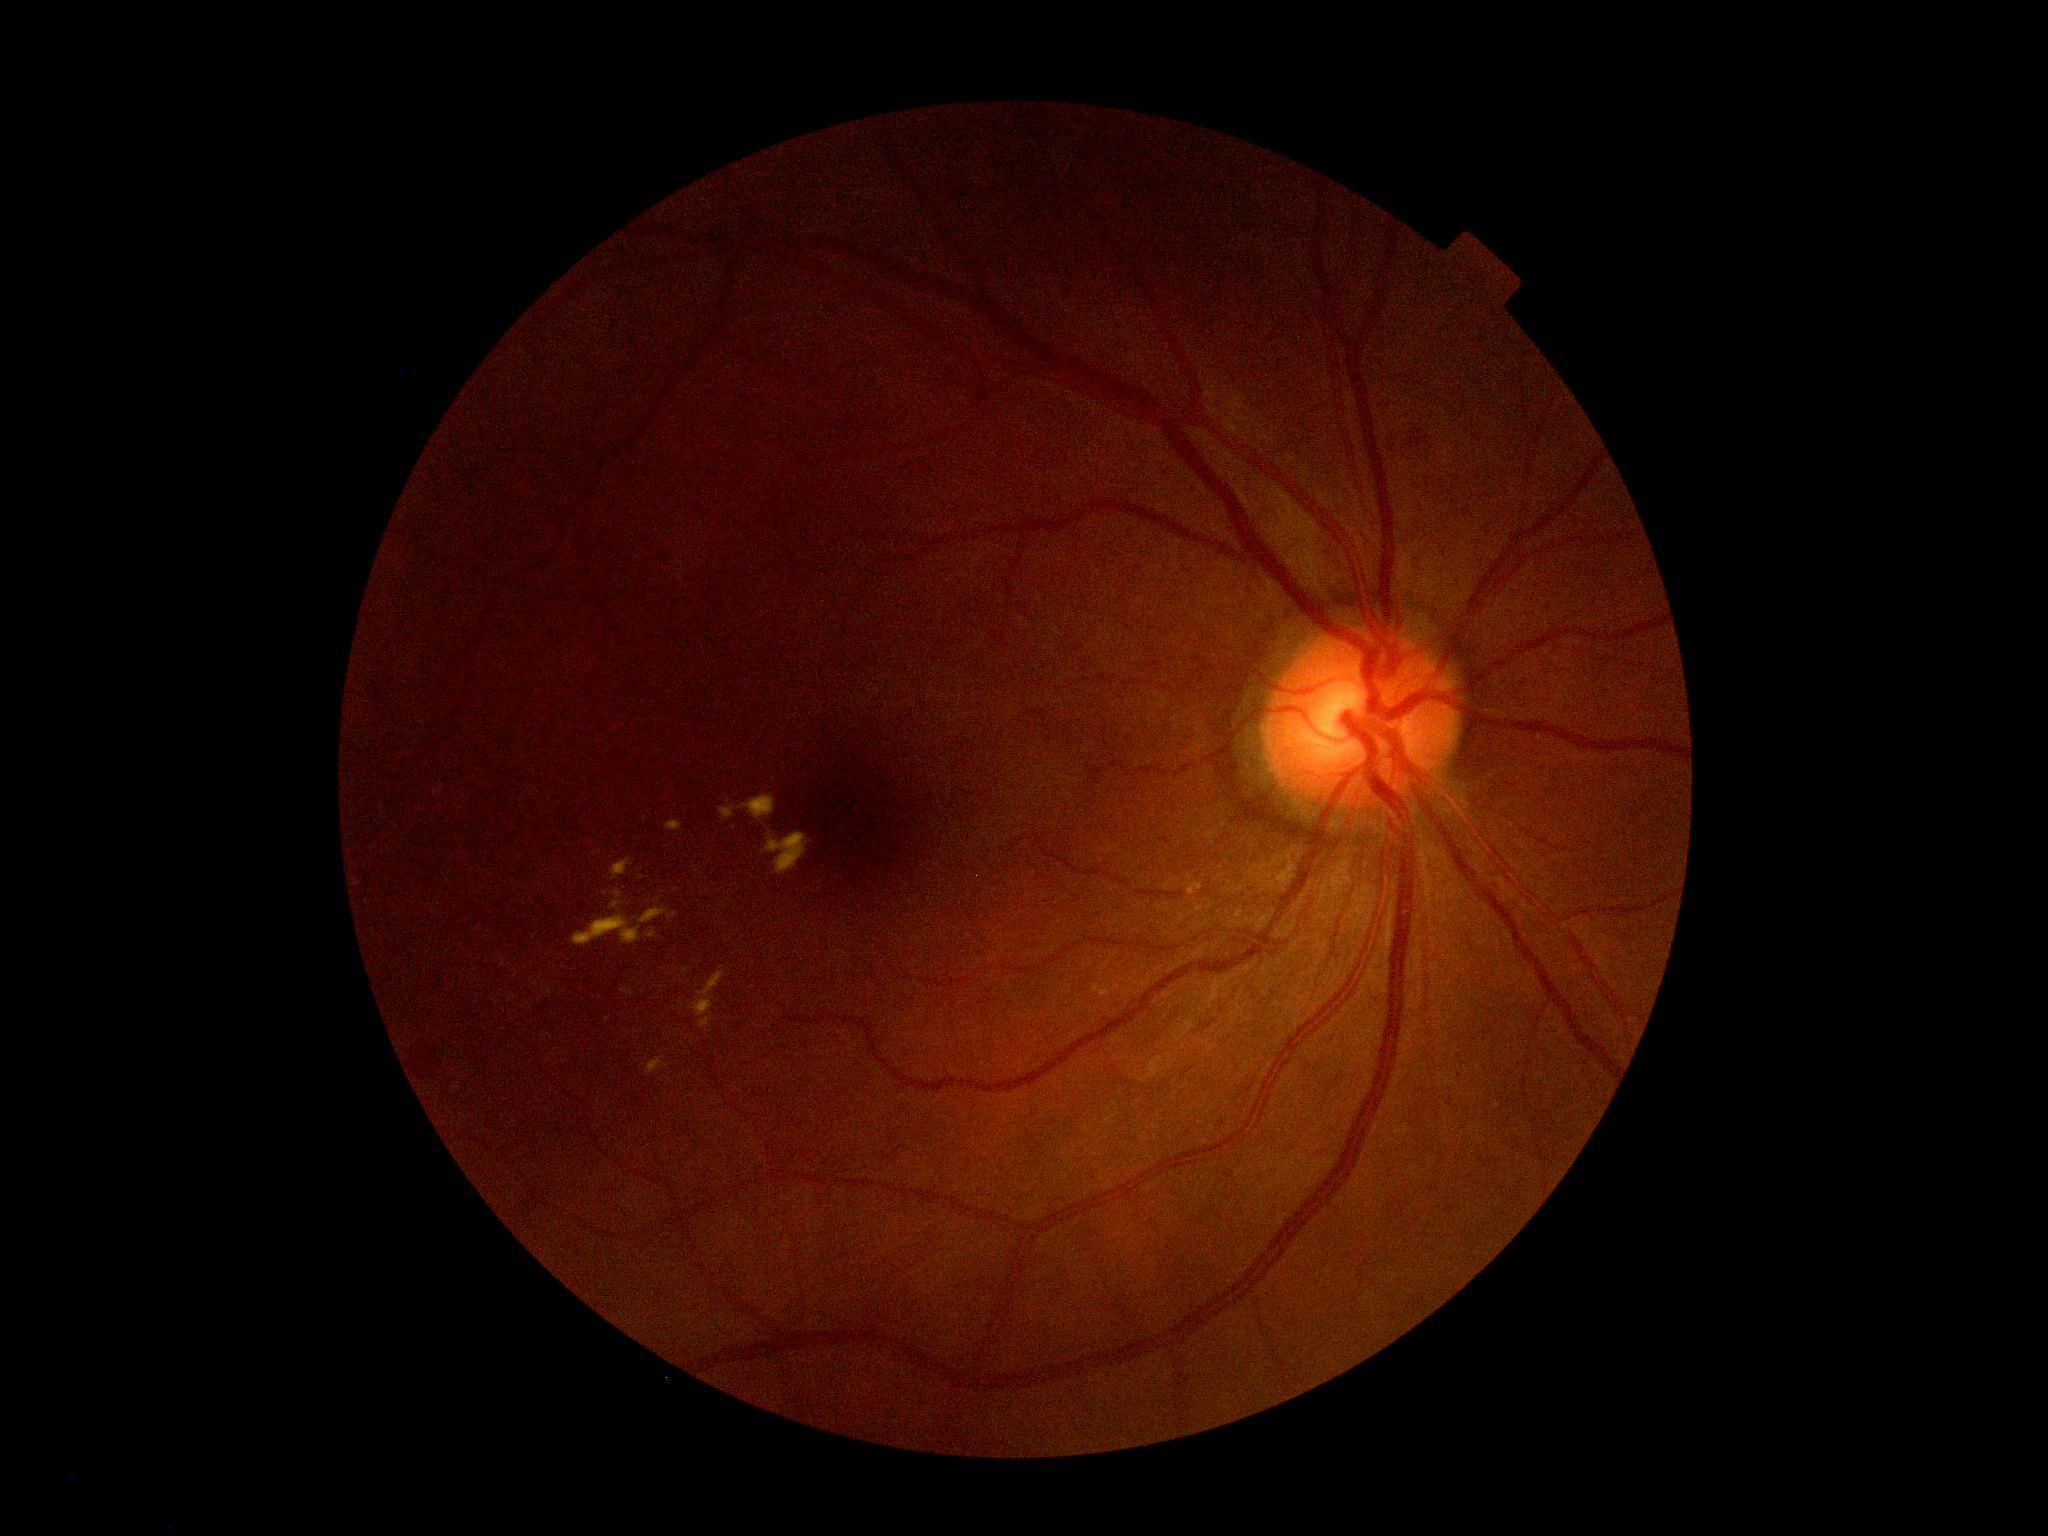
Diabetic retinopathy severity: 2/4. DR class: non-proliferative diabetic retinopathy.